Infant wide-field fundus photograph. Captured with the Phoenix ICON (100° field of view). 1240 by 1240 pixels:
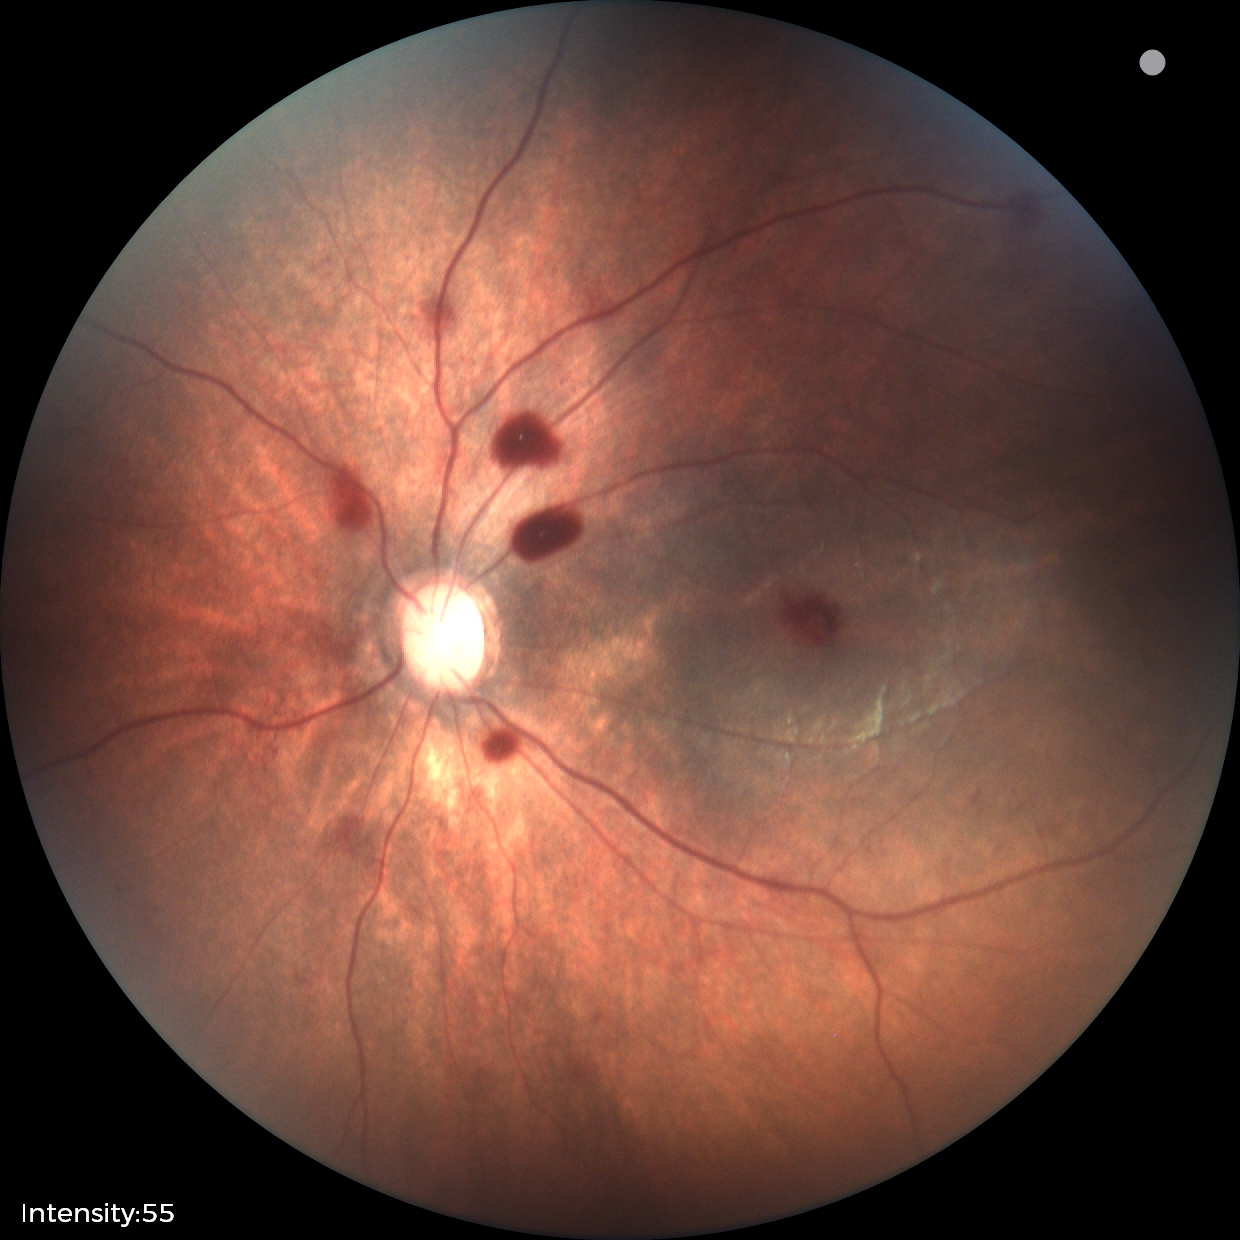 Q: What is the diagnosis from this examination?
A: retinal hemorrhages